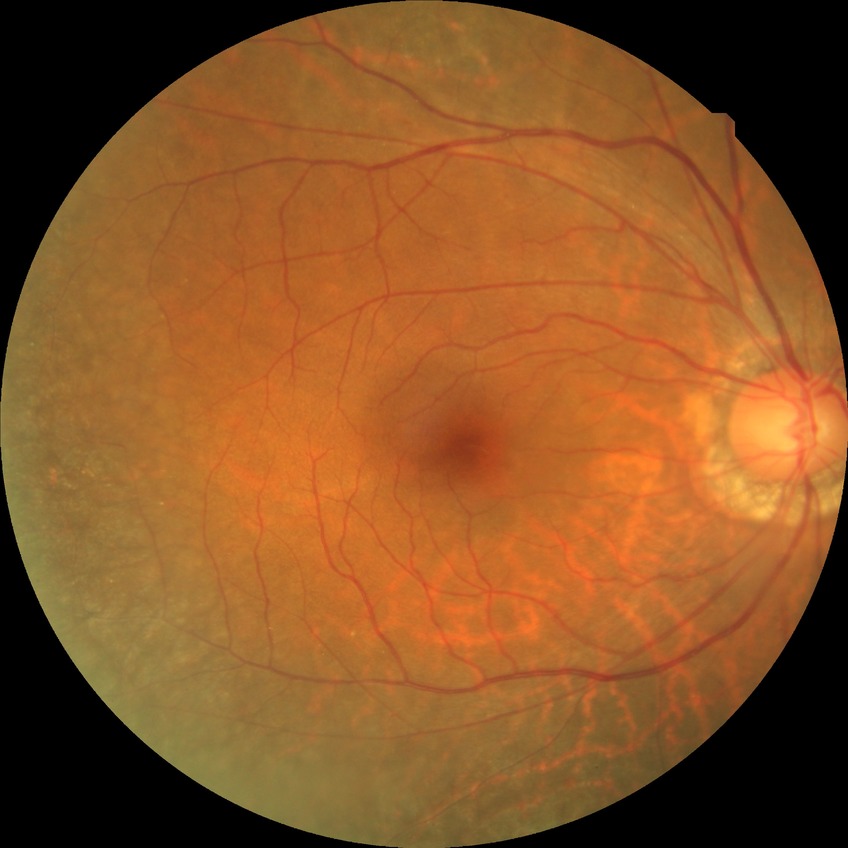
diabetic retinopathy stage: no diabetic retinopathy.